1440x1080px. Pediatric wide-field fundus photograph
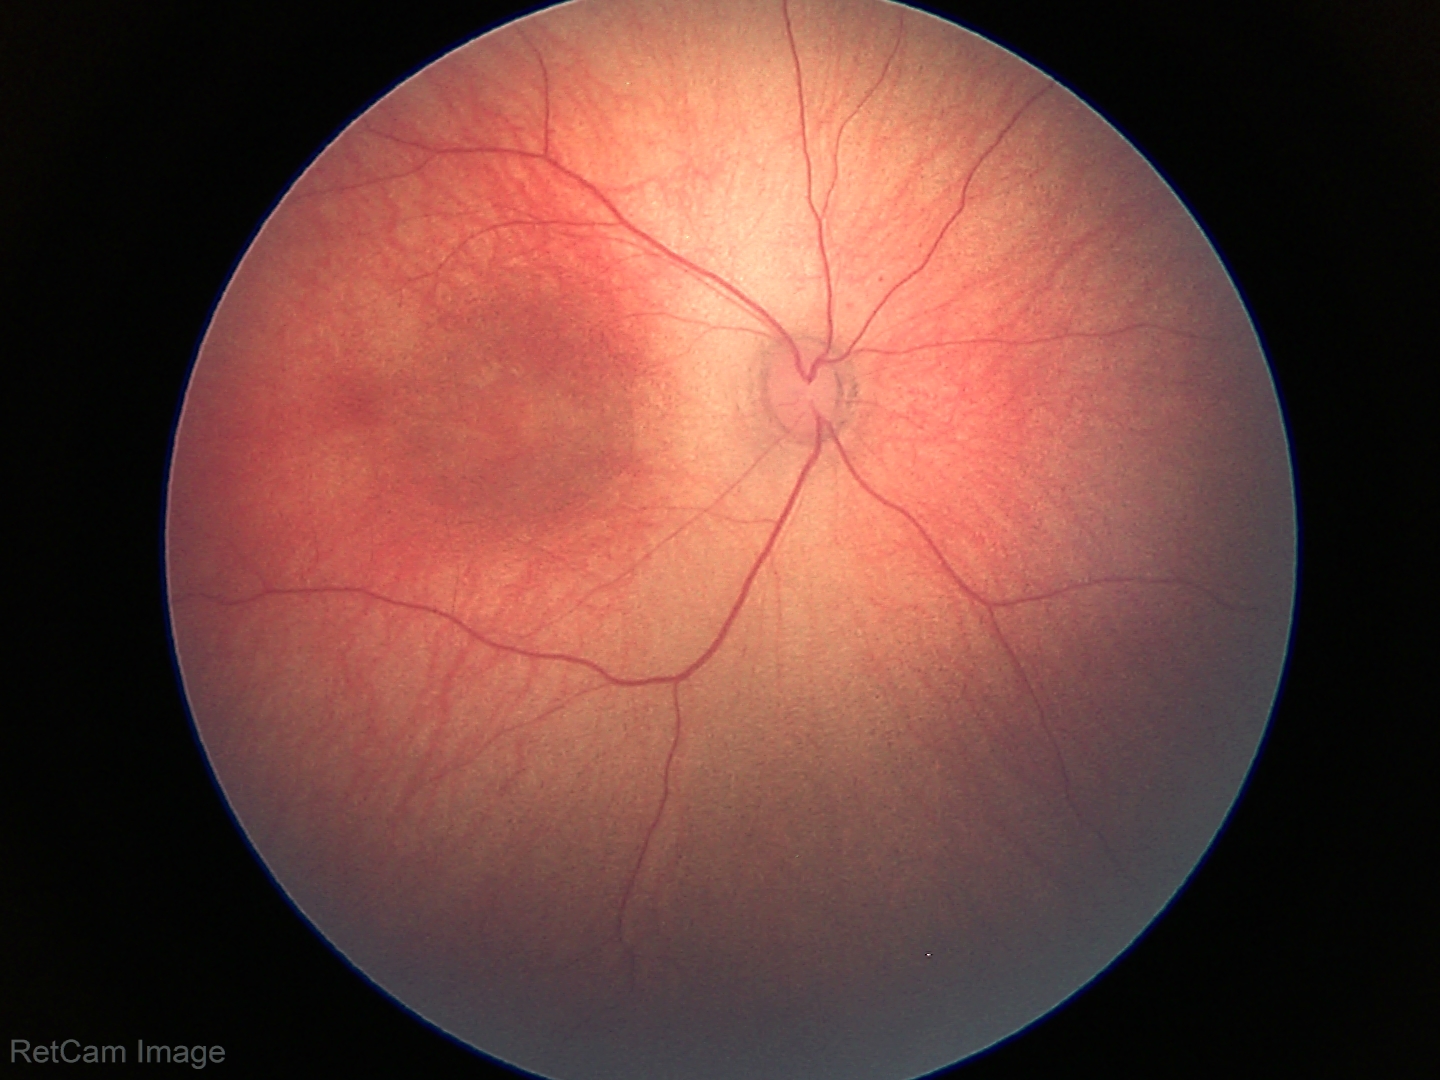
Physiological retinal appearance for postconceptual age.